Pediatric wide-field fundus photograph:
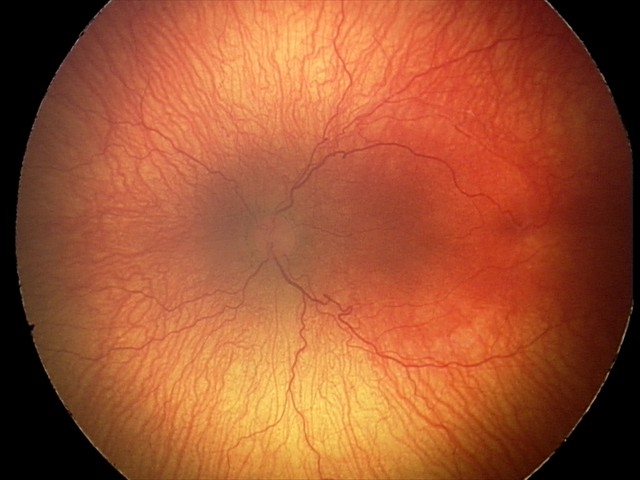

Examination diagnosed as aggressive retinopathy of prematurity.
Plus disease was diagnosed.